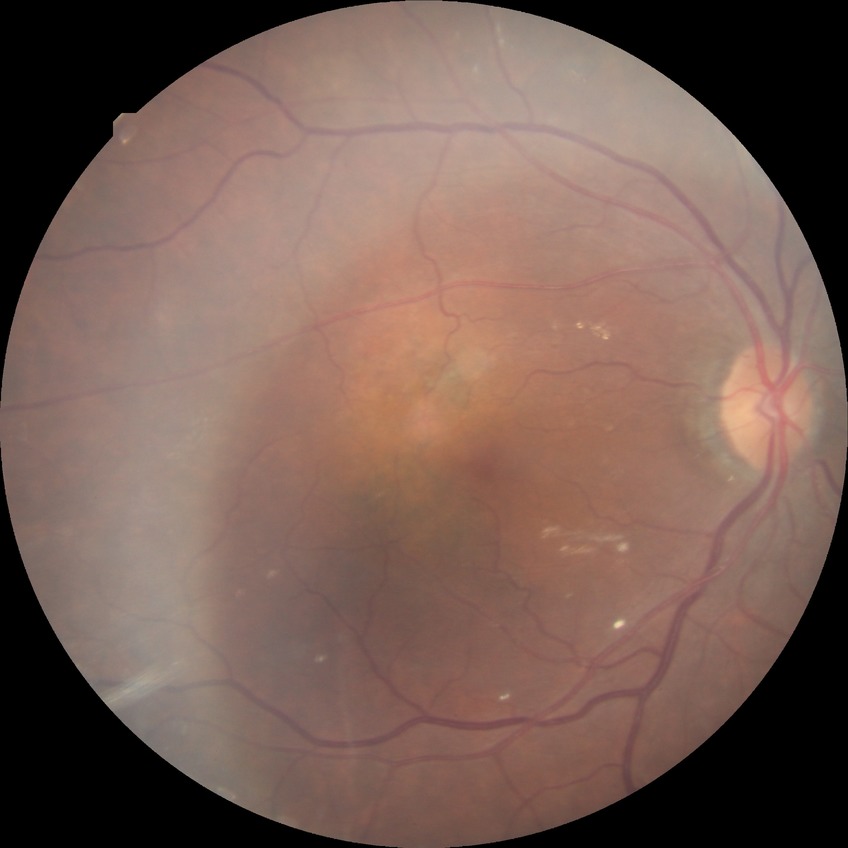

  proliferative_class: non-proliferative diabetic retinopathy
  davis_grade: simple diabetic retinopathy